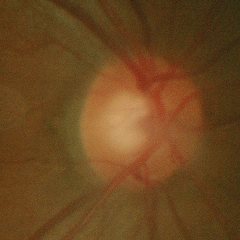
Optic disc appearance consistent with no glaucomatous changes.